CFP.
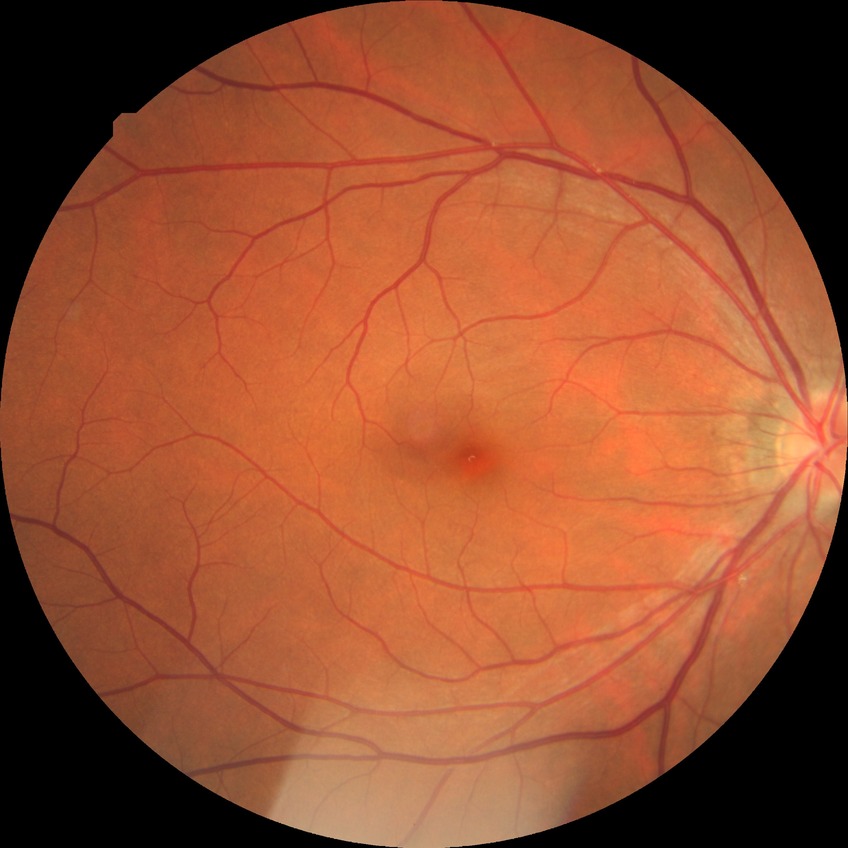
Diabetic retinopathy (DR): NDR (no diabetic retinopathy).